NIDEK AFC-230 fundus camera: 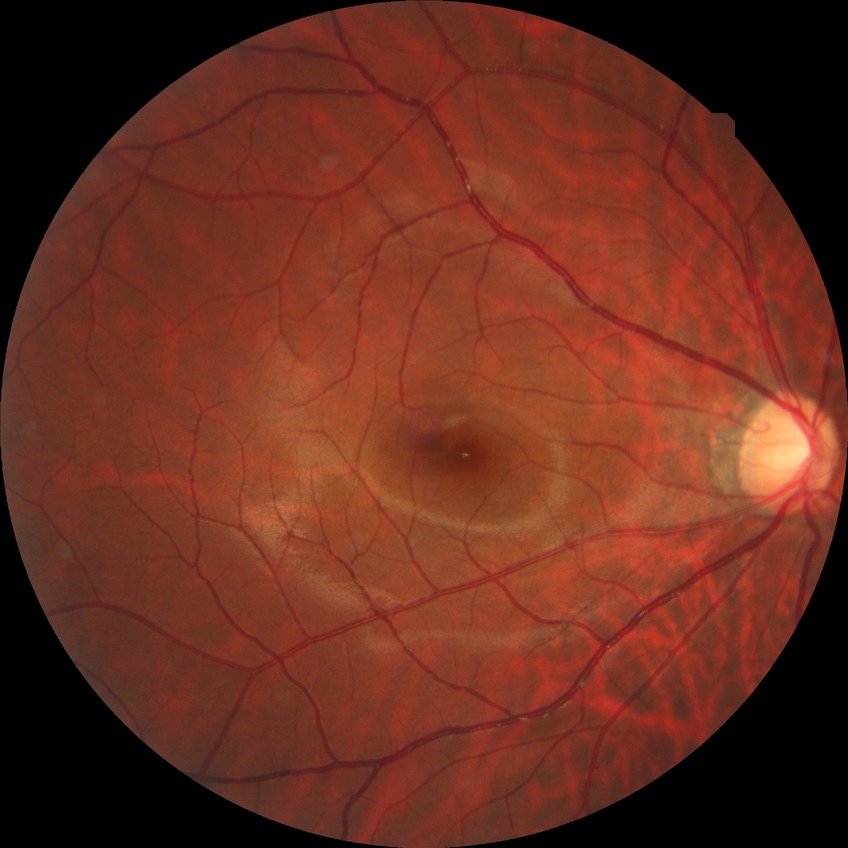 diabetic retinopathy (DR) = no diabetic retinopathy (NDR).